Wide-field fundus image from infant ROP screening.
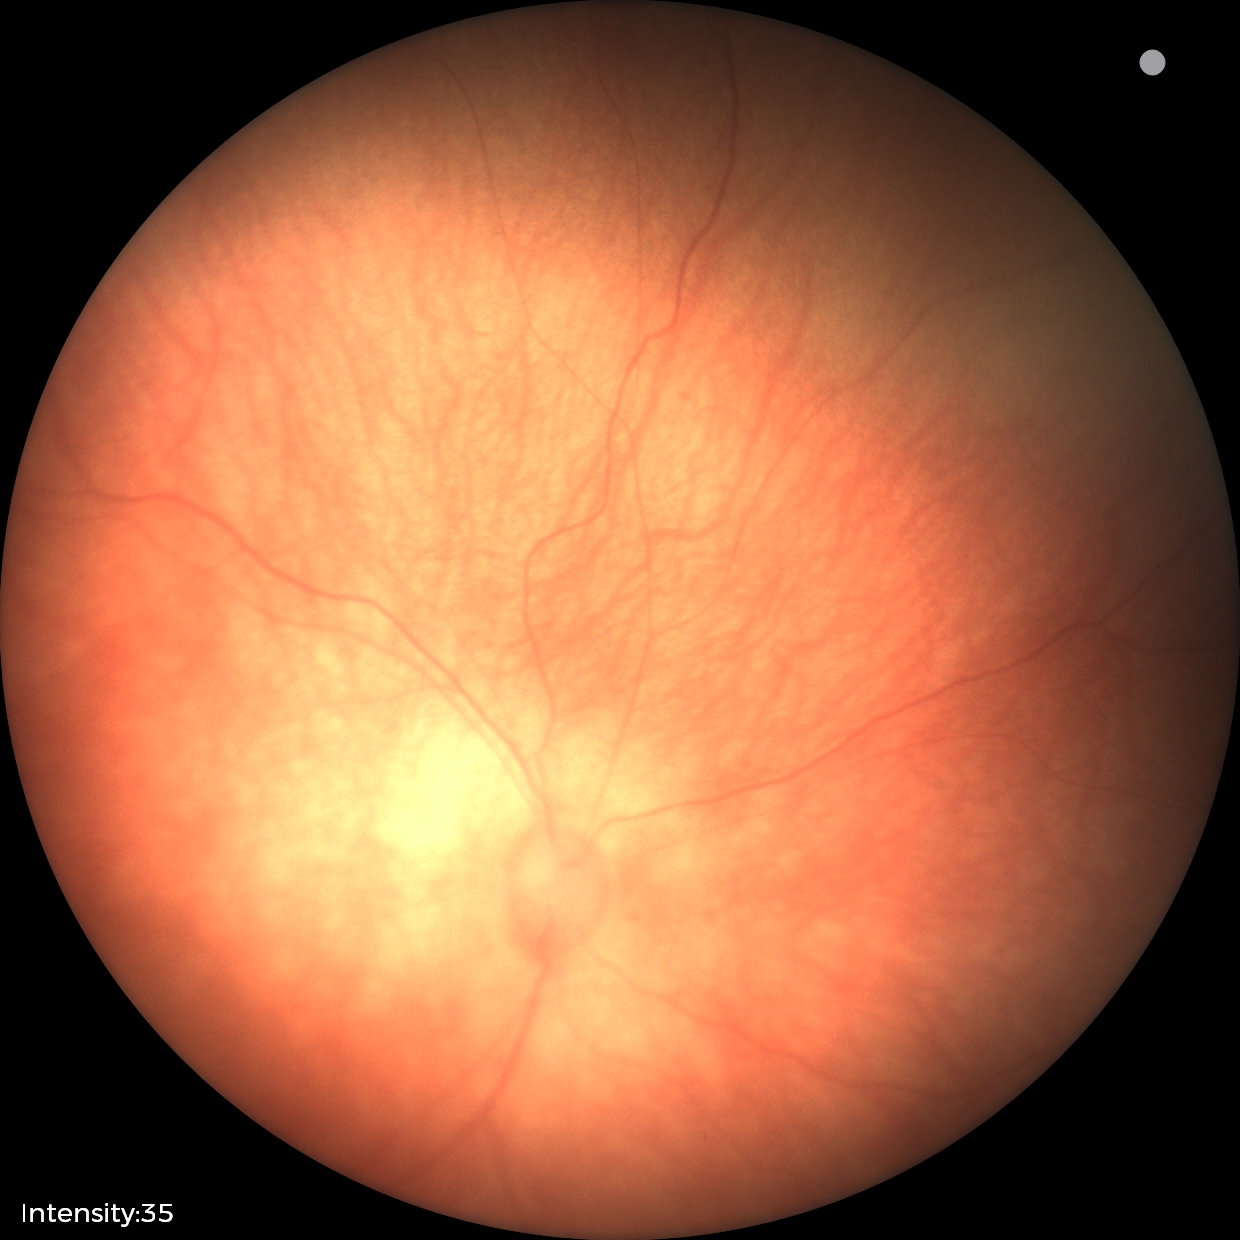
Screening examination diagnosed as physiological.